Color fundus photograph — 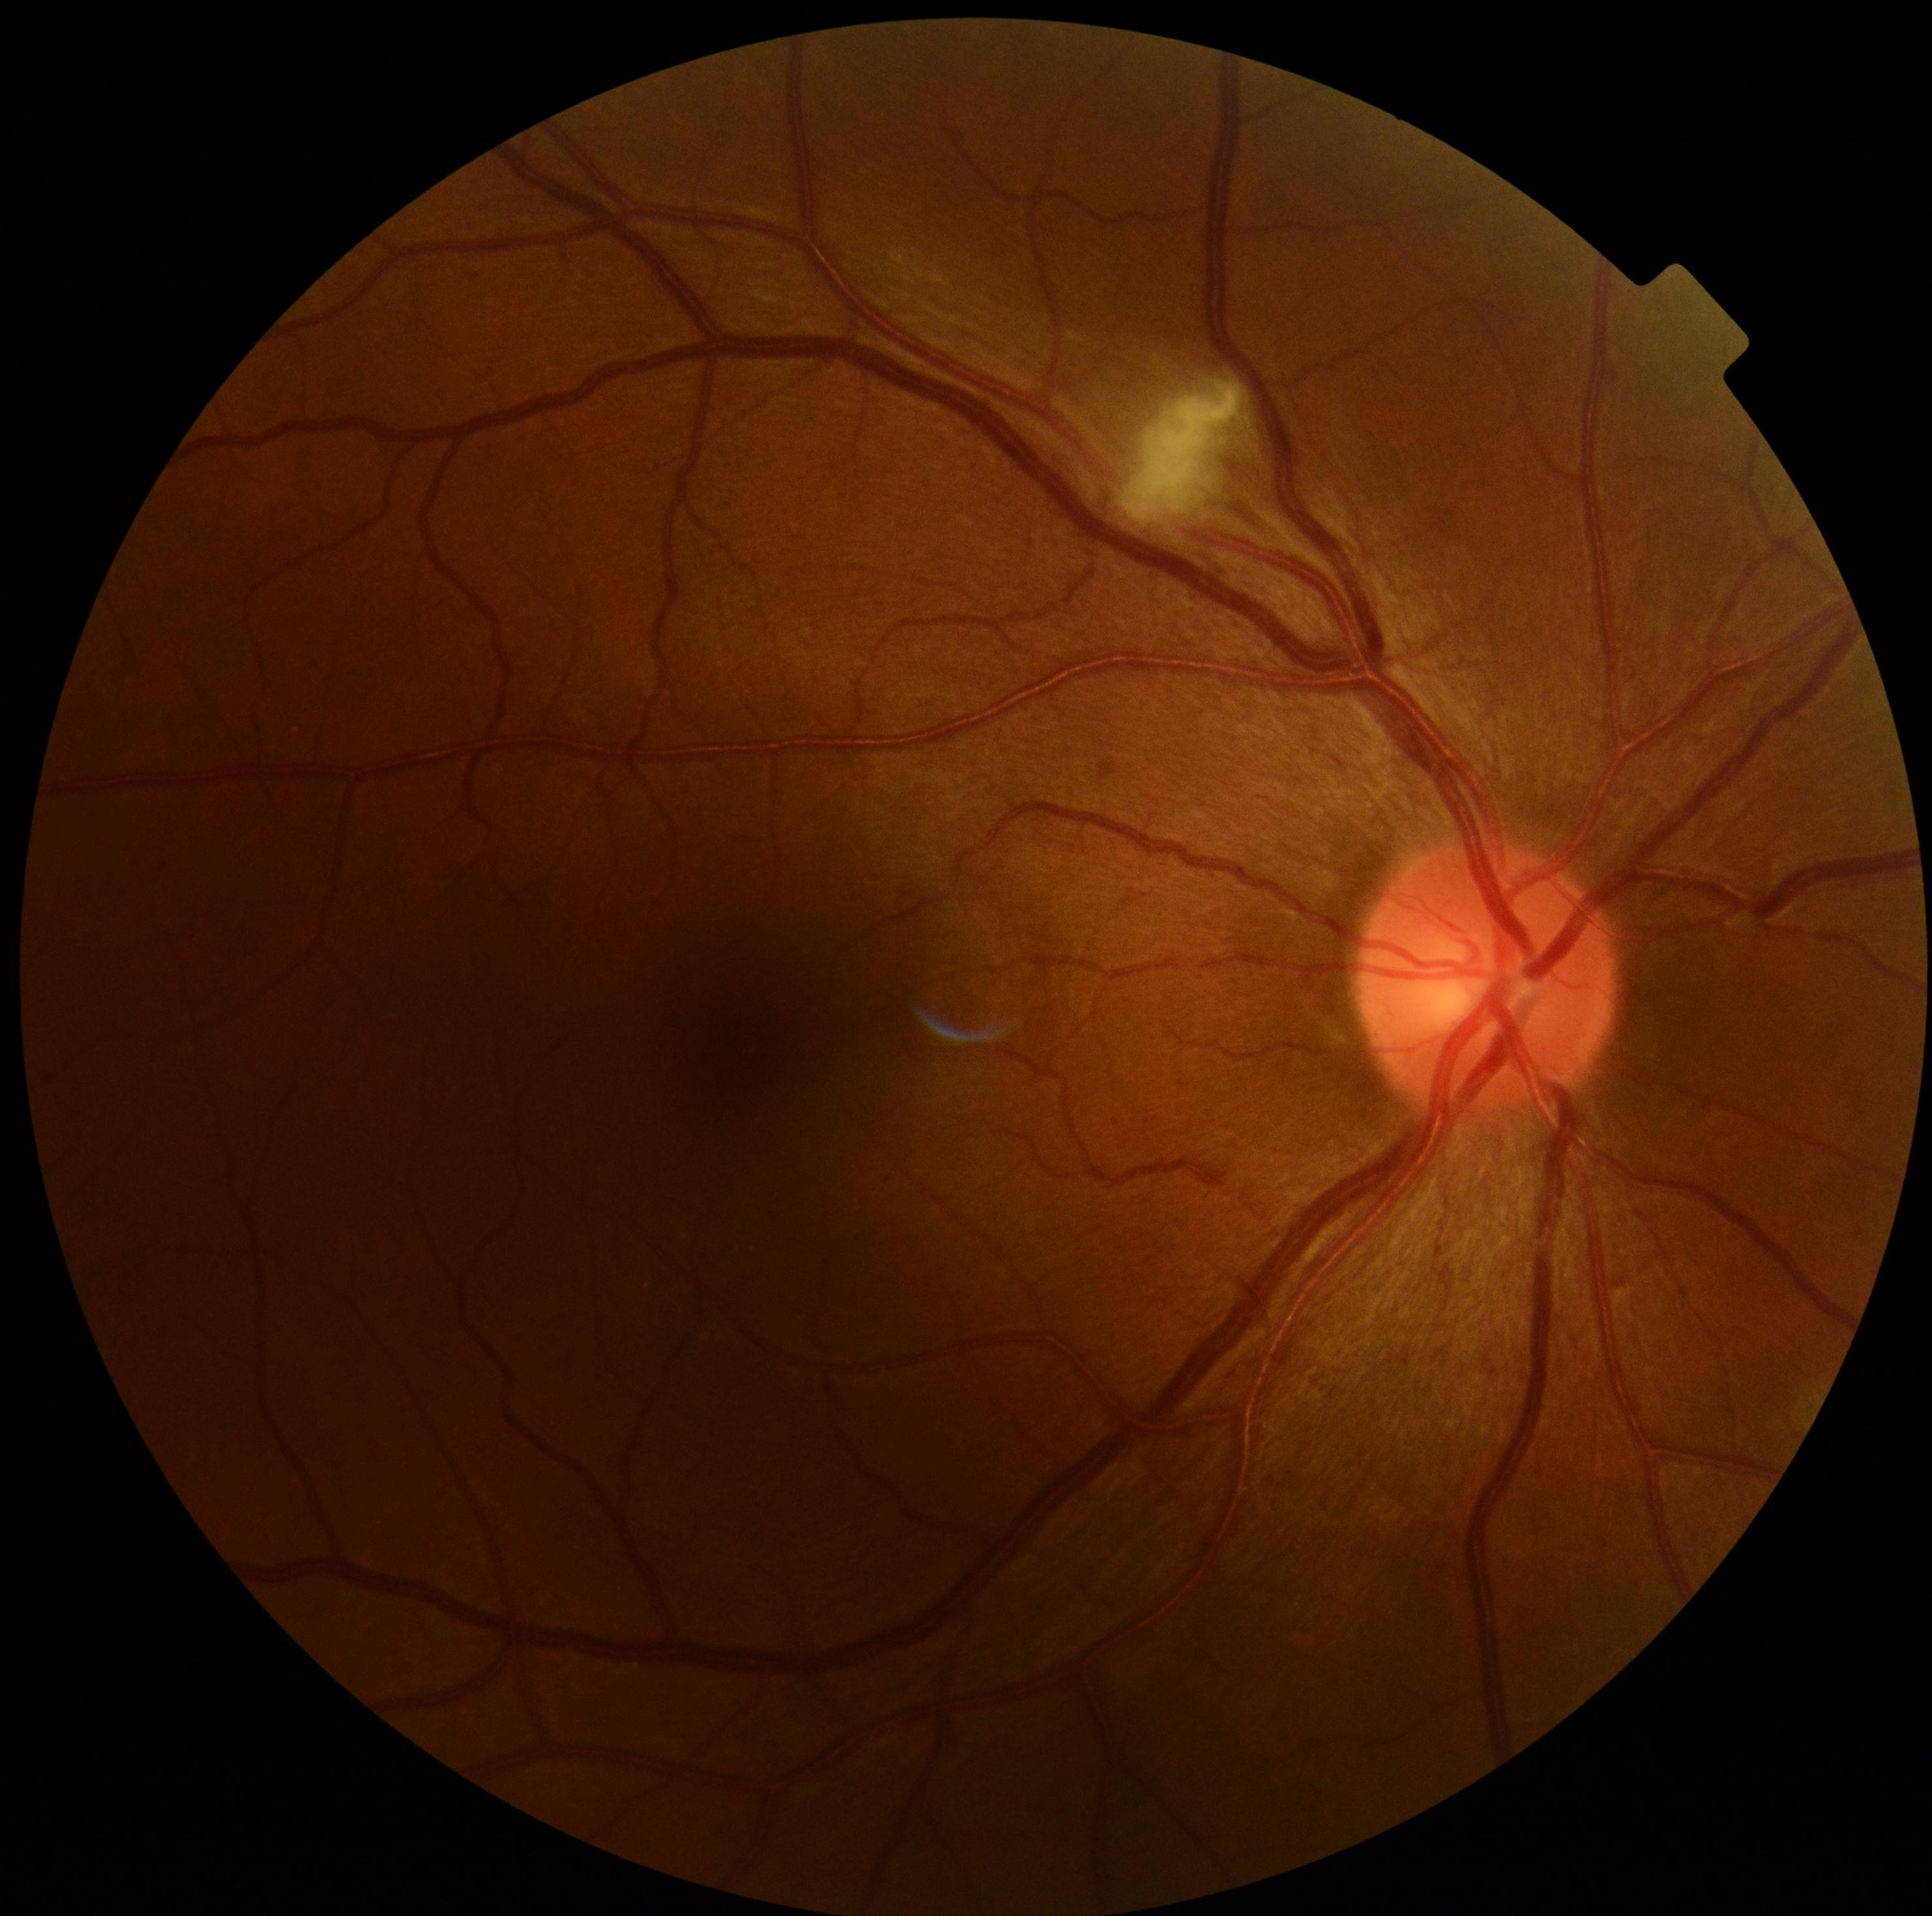

DR stage: moderate non-proliferative diabetic retinopathy (grade 2).